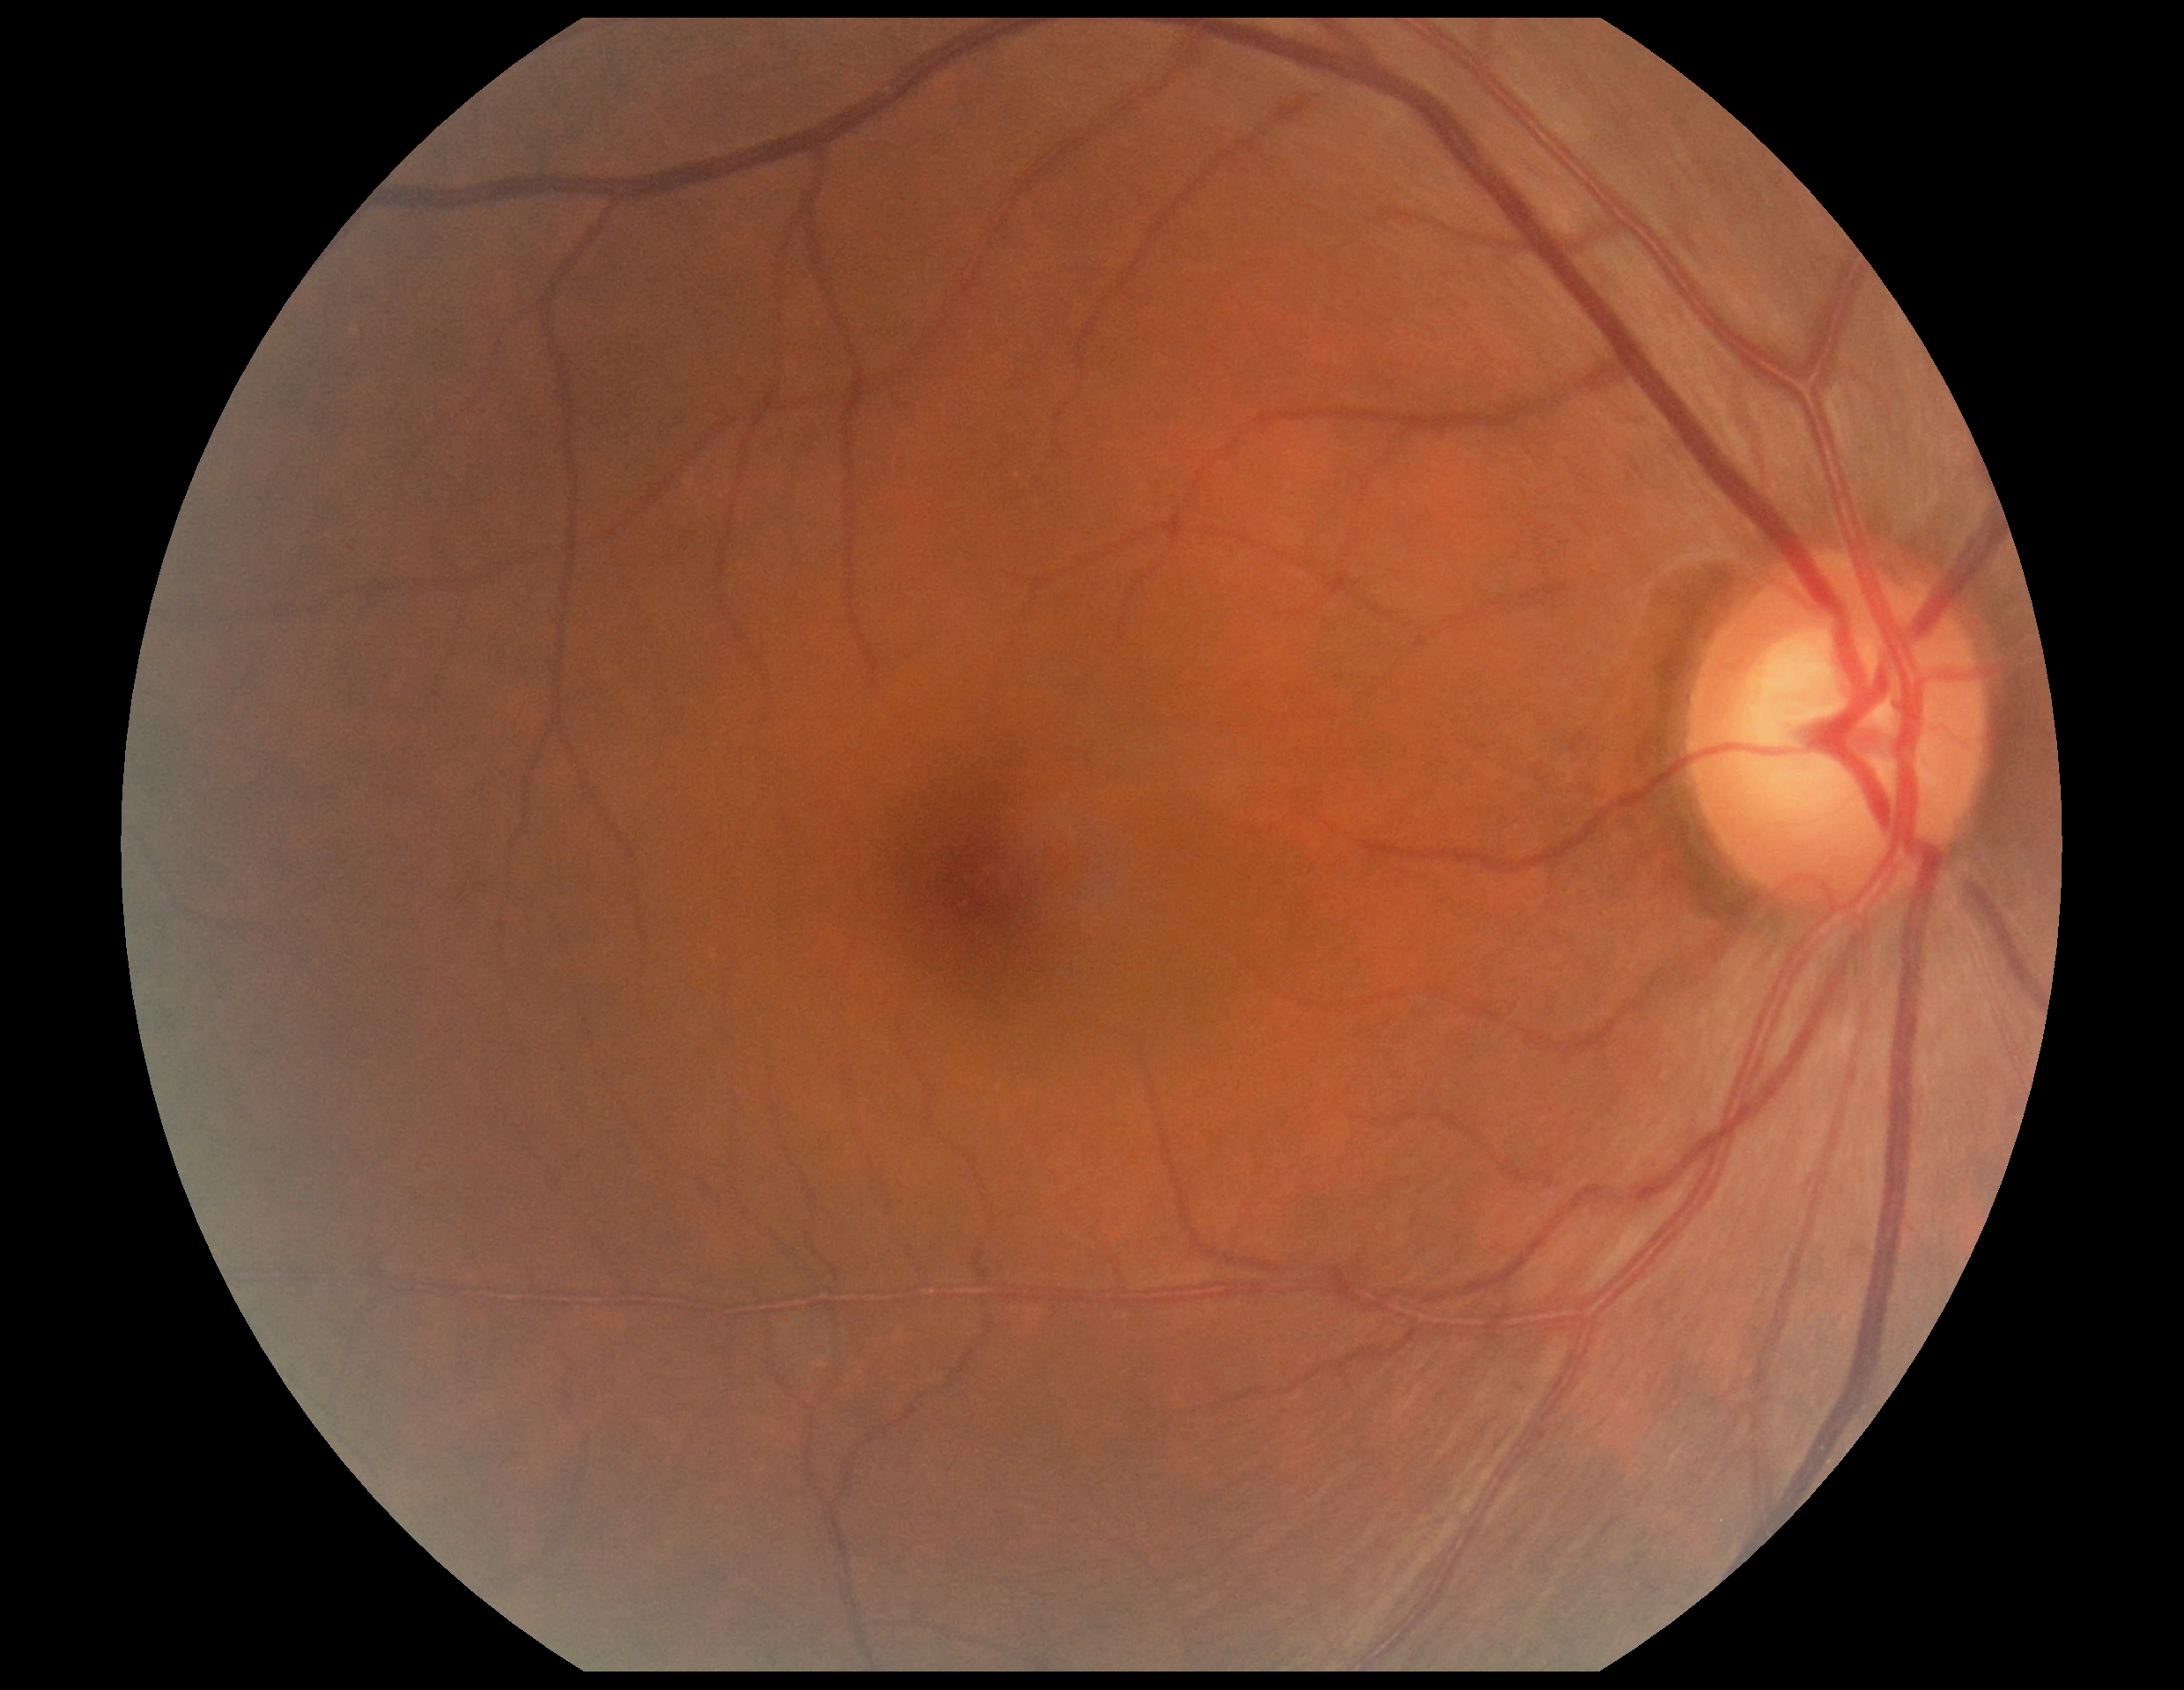 DR grade is 0 (no apparent retinopathy).
No apparent diabetic retinopathy.